45° field of view · Davis DR grading: 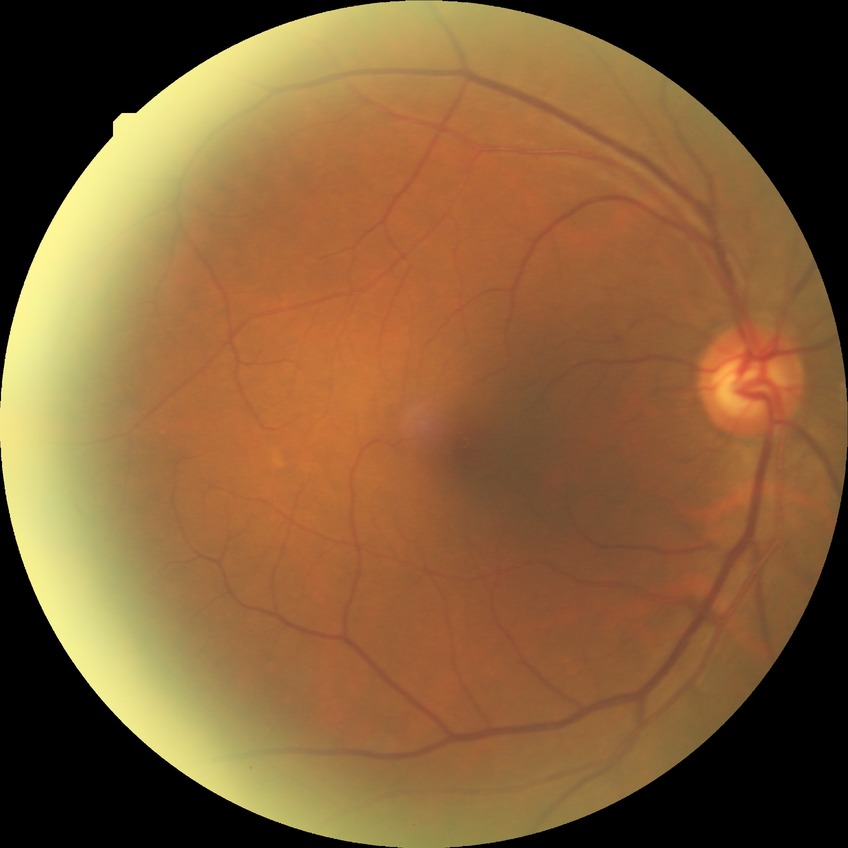 Diabetic retinopathy severity is simple diabetic retinopathy. Disease class: non-proliferative diabetic retinopathy.